CFP. 1932x1910px.
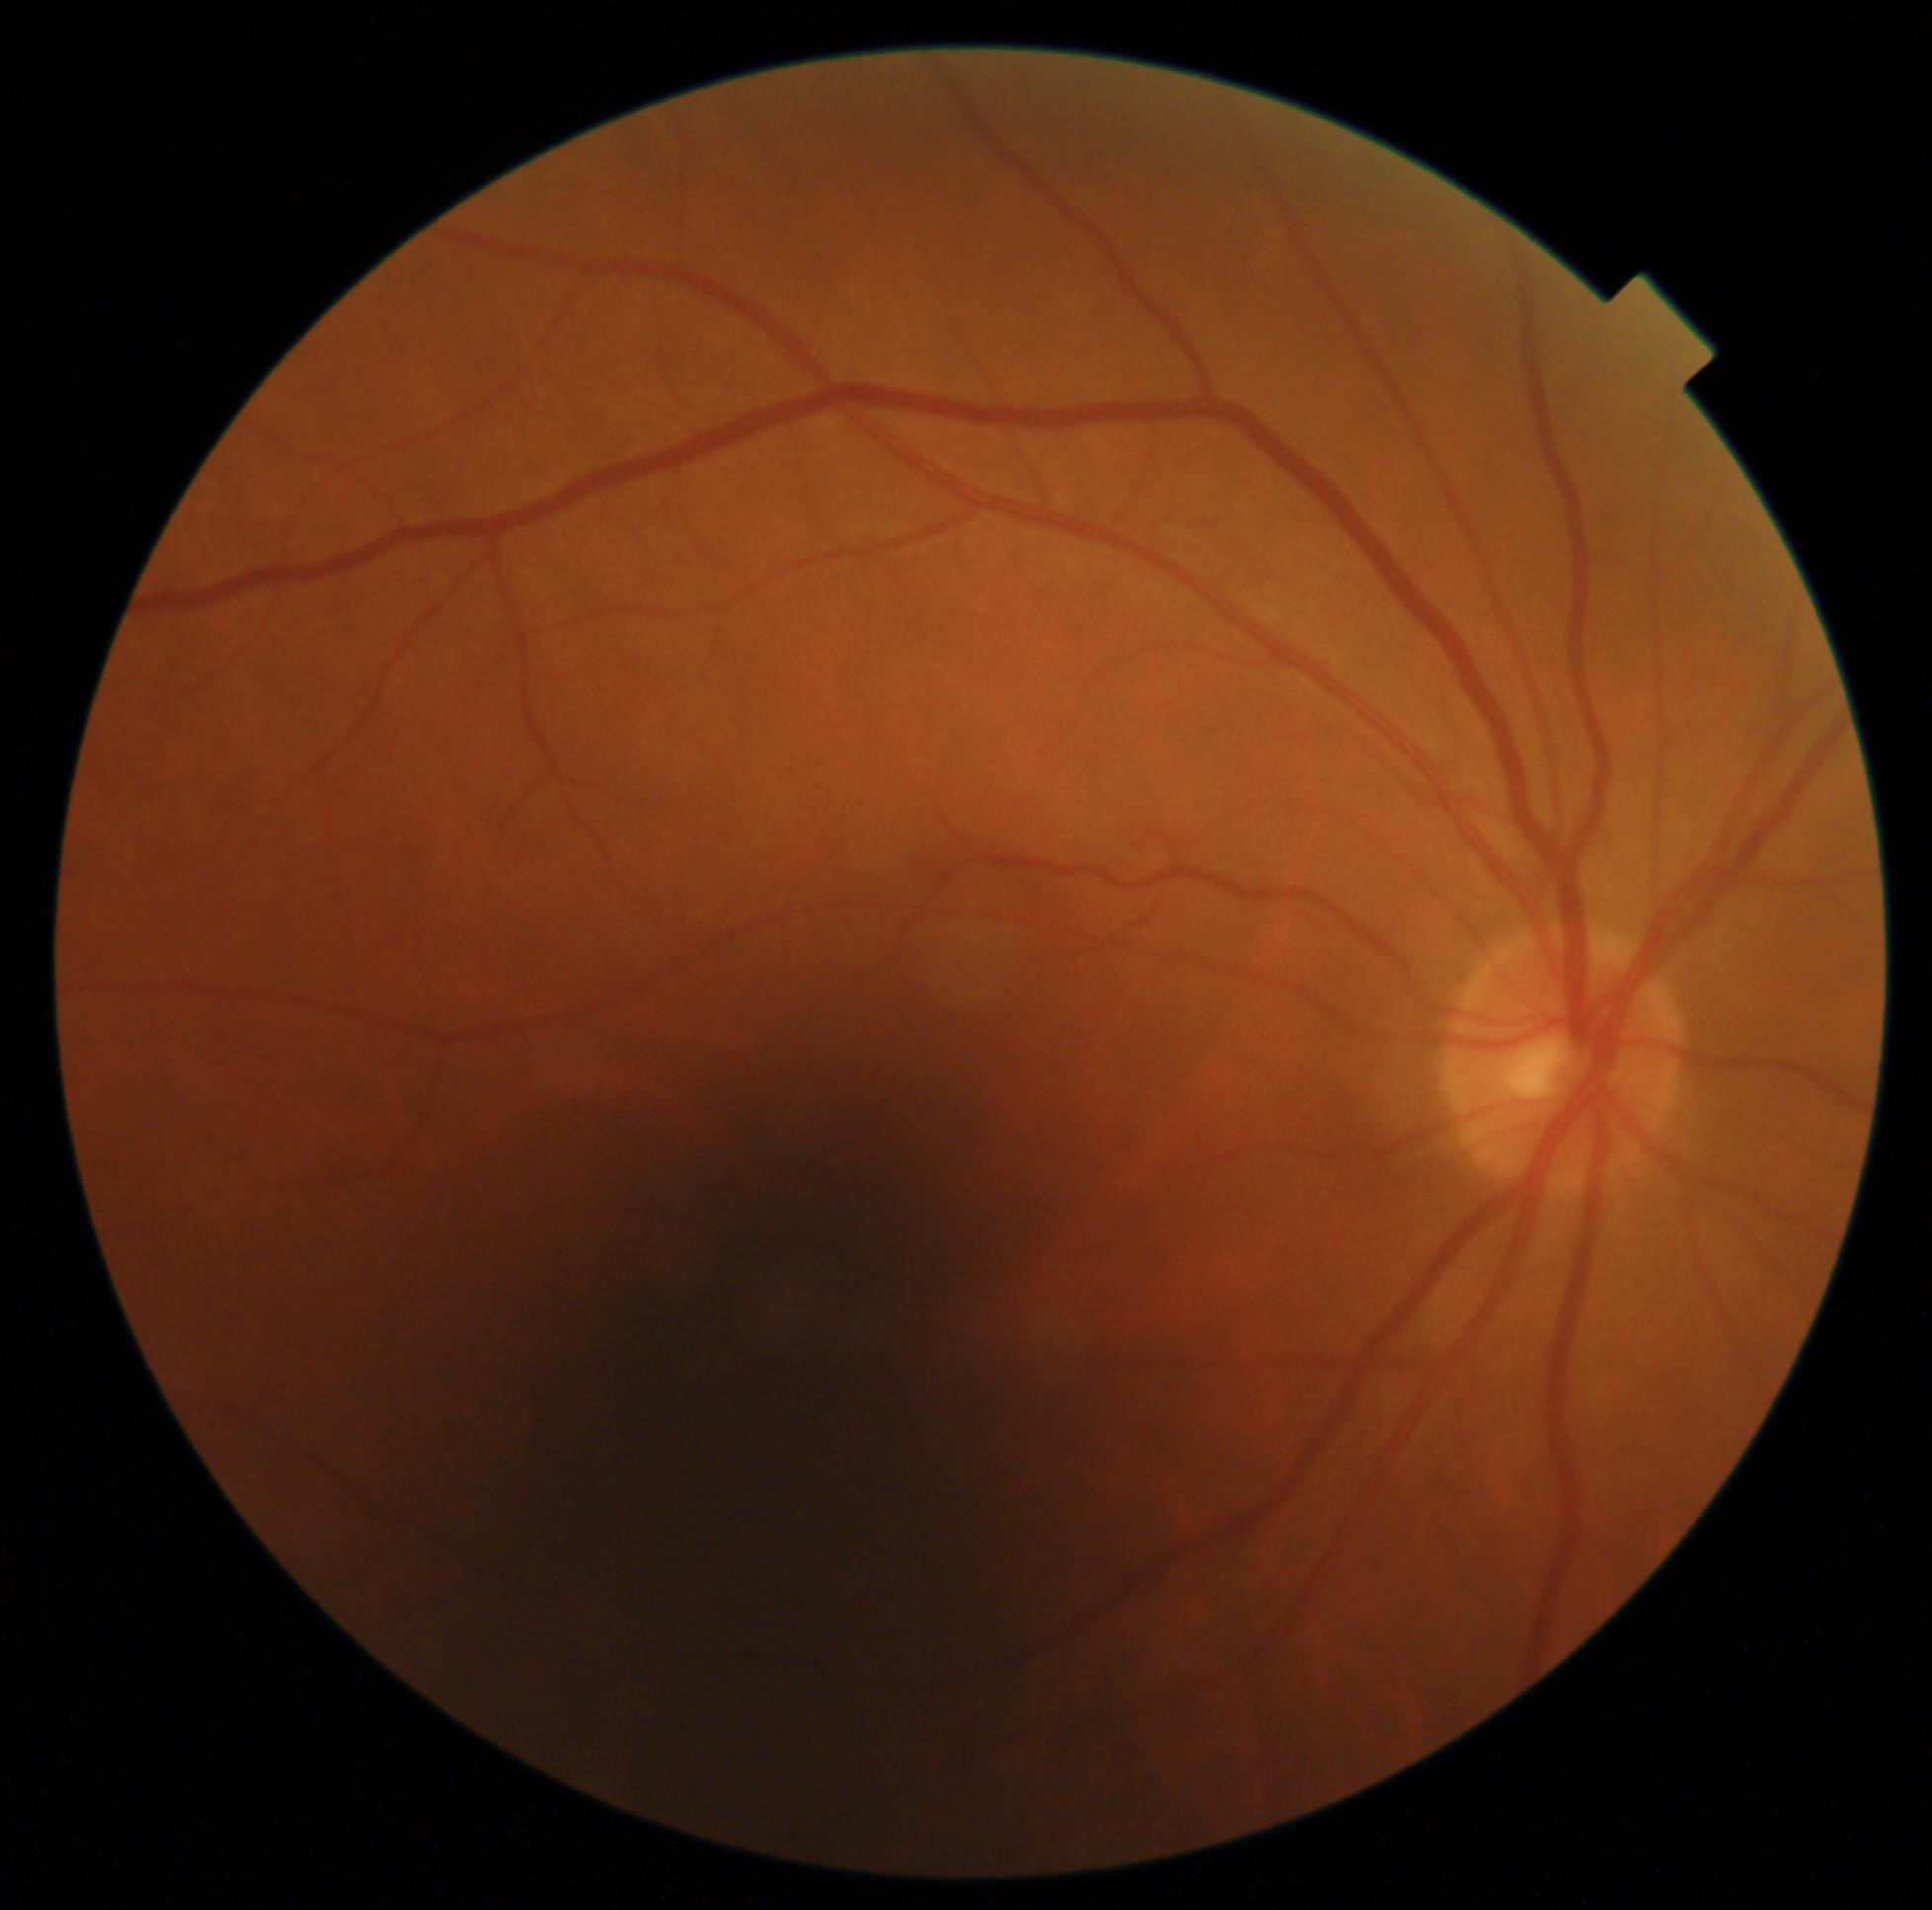 Diabetic retinopathy severity: grade 0.